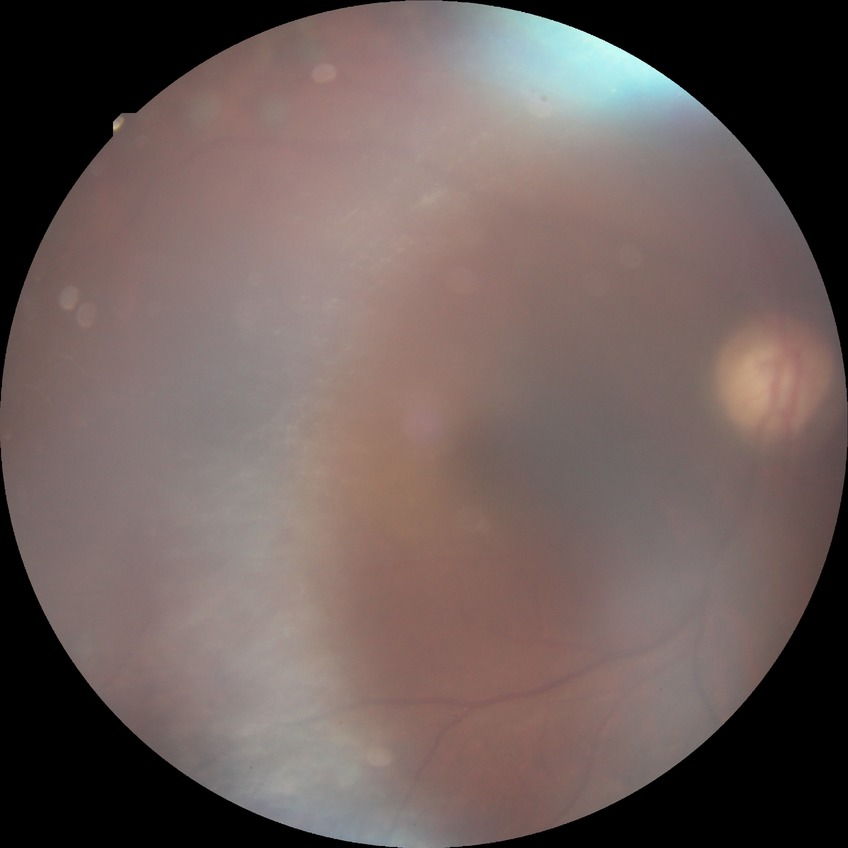

Diabetic retinopathy (DR): PDR (proliferative diabetic retinopathy).